2048x1536px.
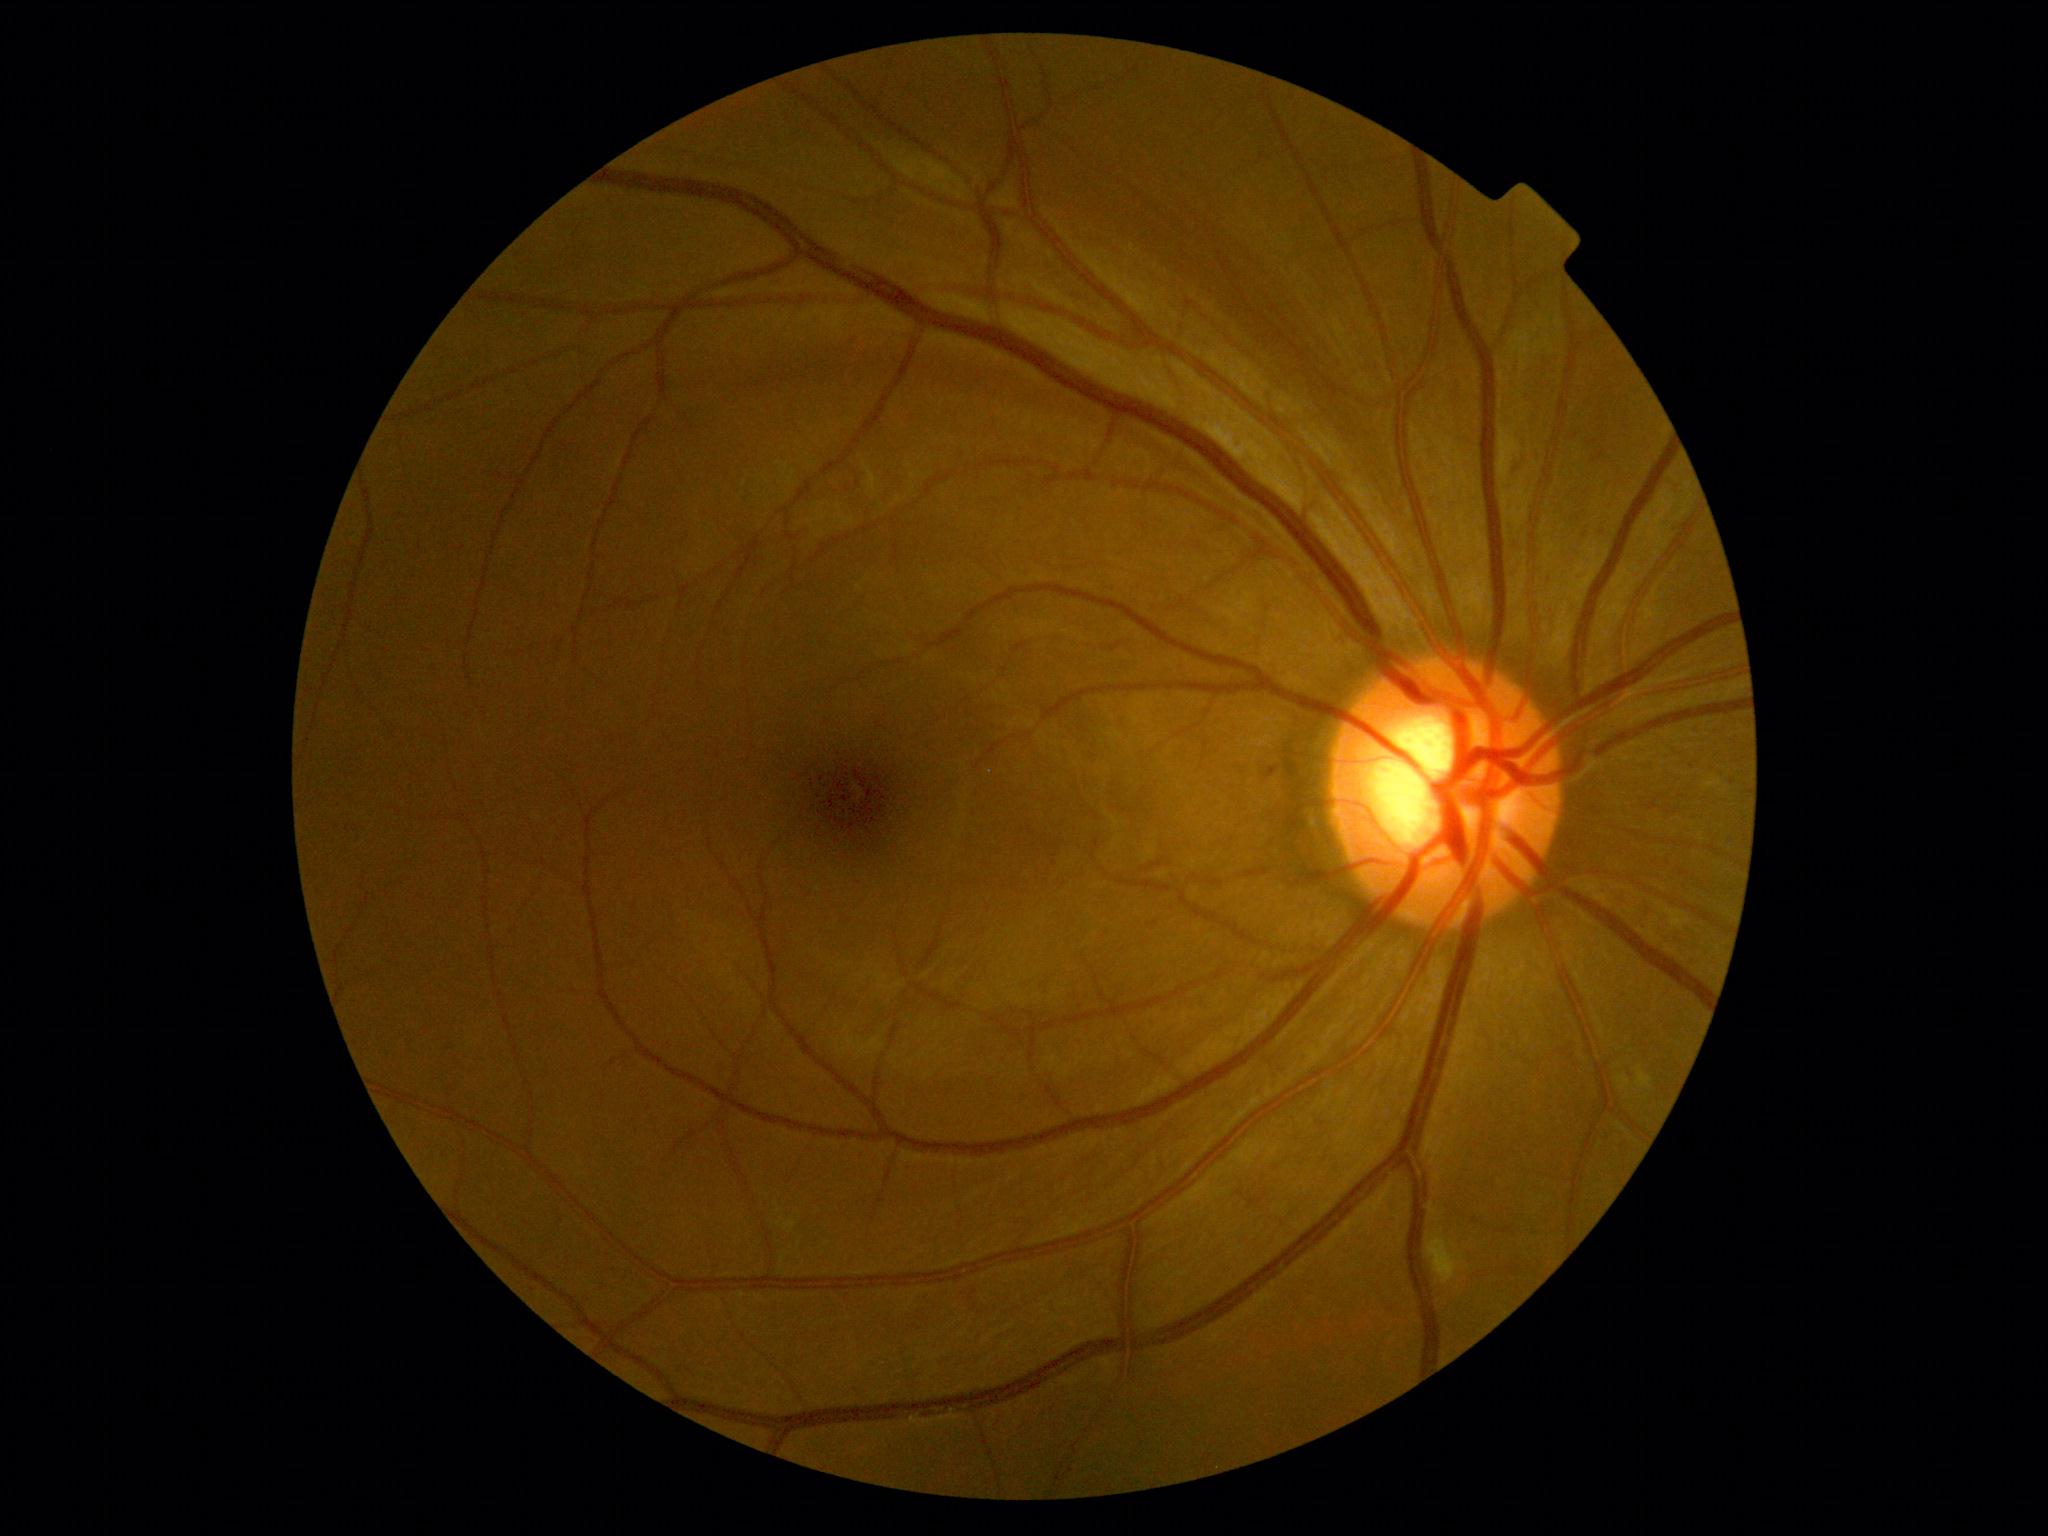

Diabetic retinopathy (DR): 1. DR class: non-proliferative diabetic retinopathy.